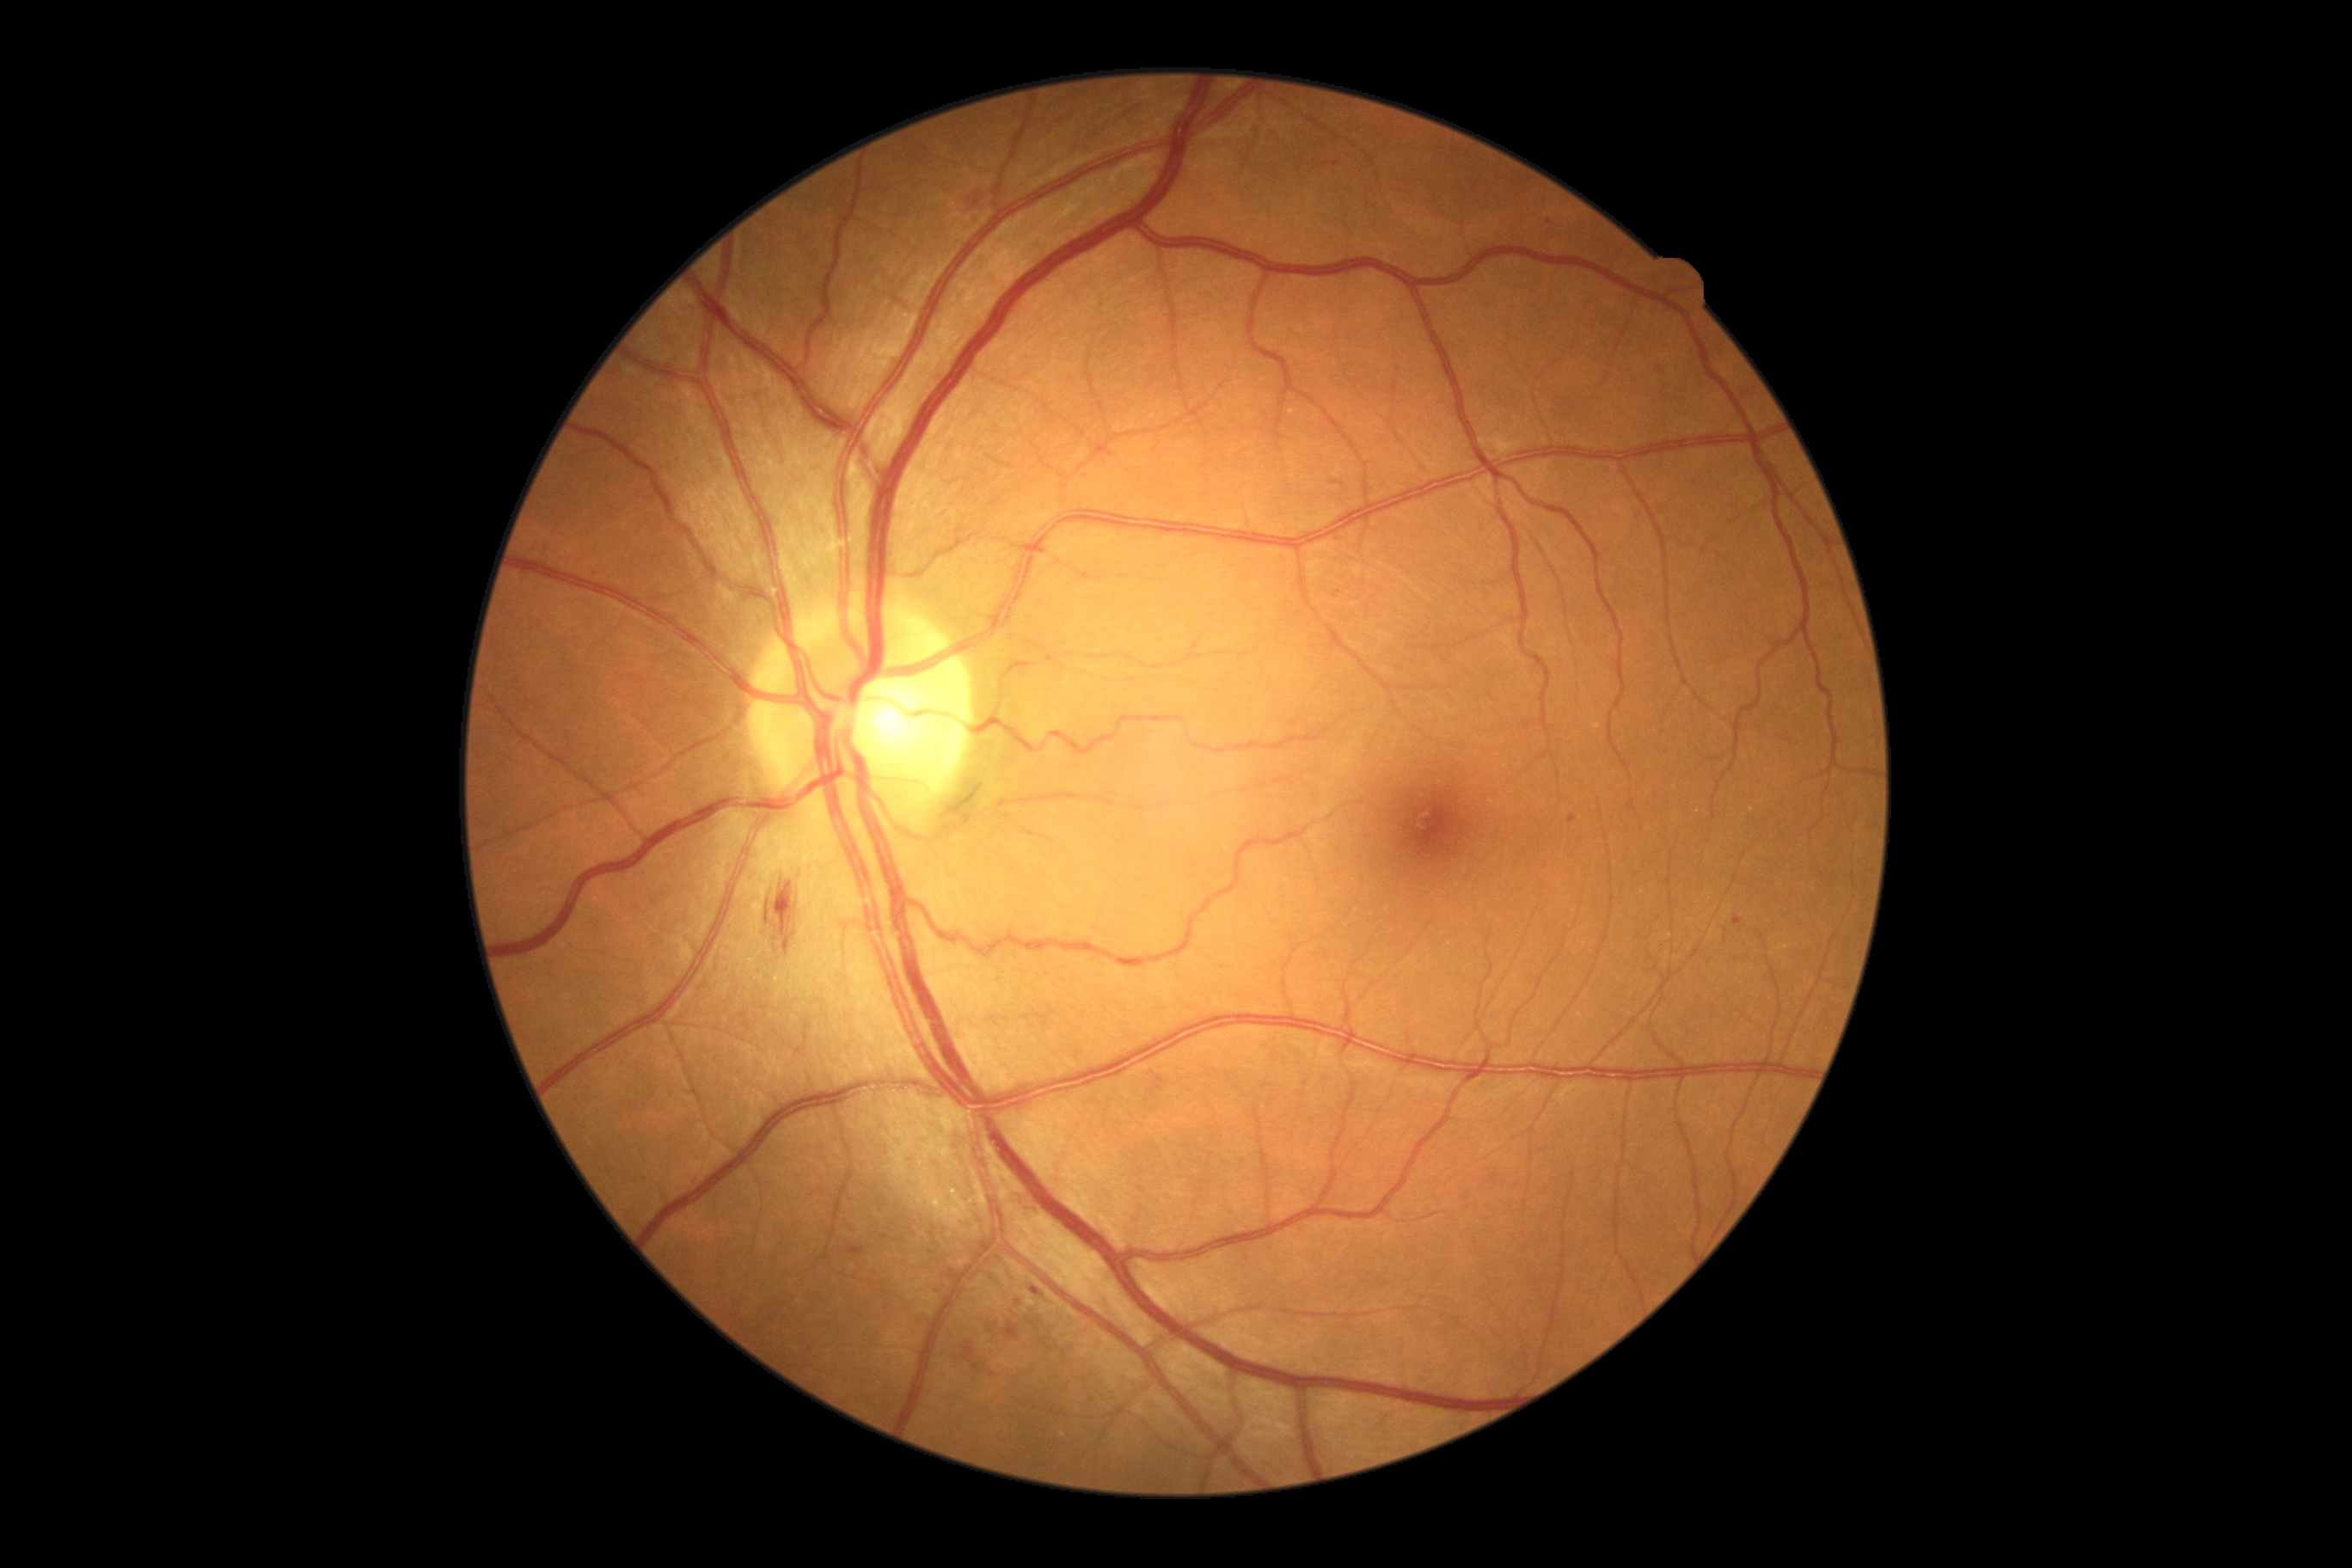

Diabetic retinopathy (DR) is grade 2 (moderate NPDR).